Acquired with a NIDEK AFC-230 · 848 by 848 pixels
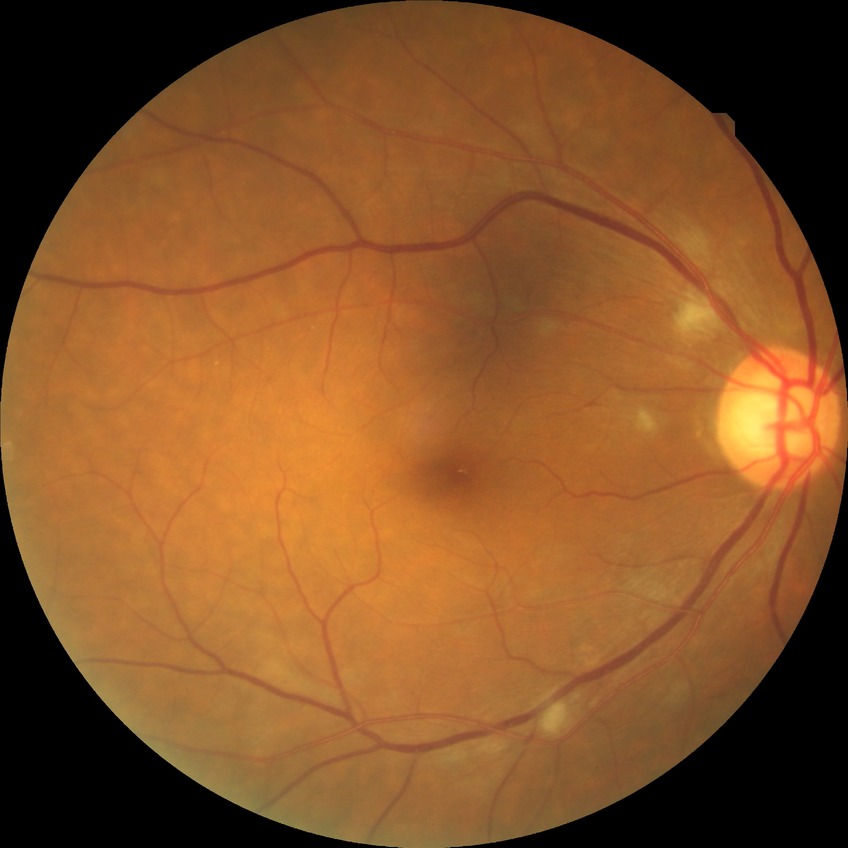

{
  "davis_grade": "PPDR"
}